Wide-field contact fundus photograph of an infant
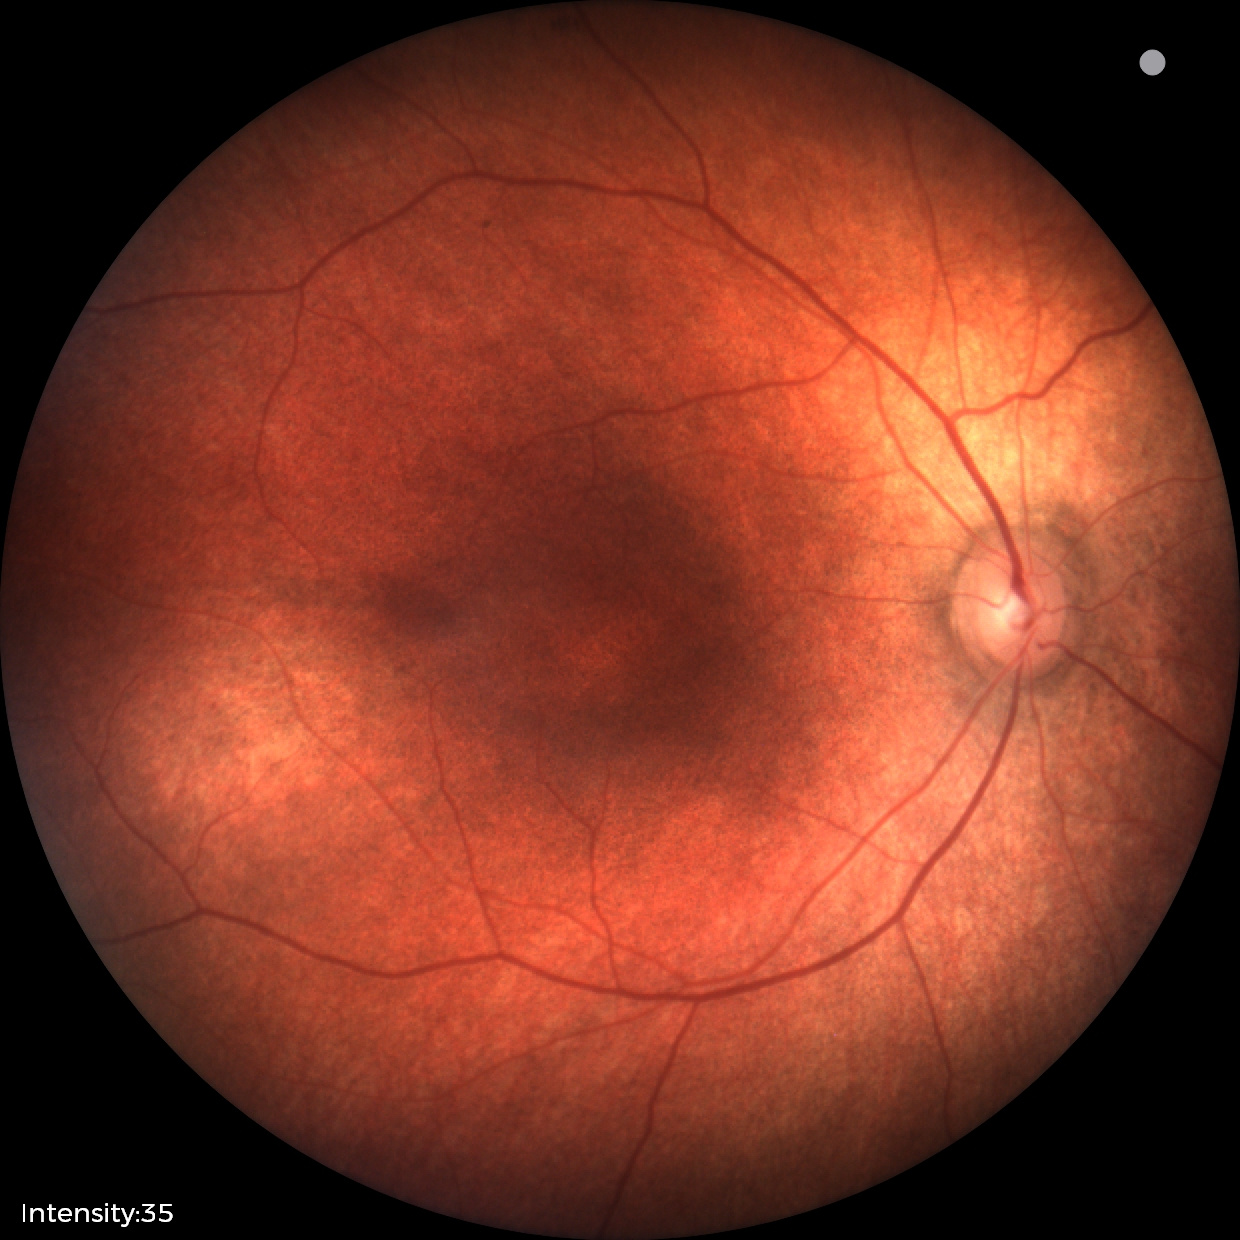
Assessment: physiological appearance.